Image size 1440x1080; Natus RetCam Envision, 130° FOV; pediatric wide-field fundus photograph: 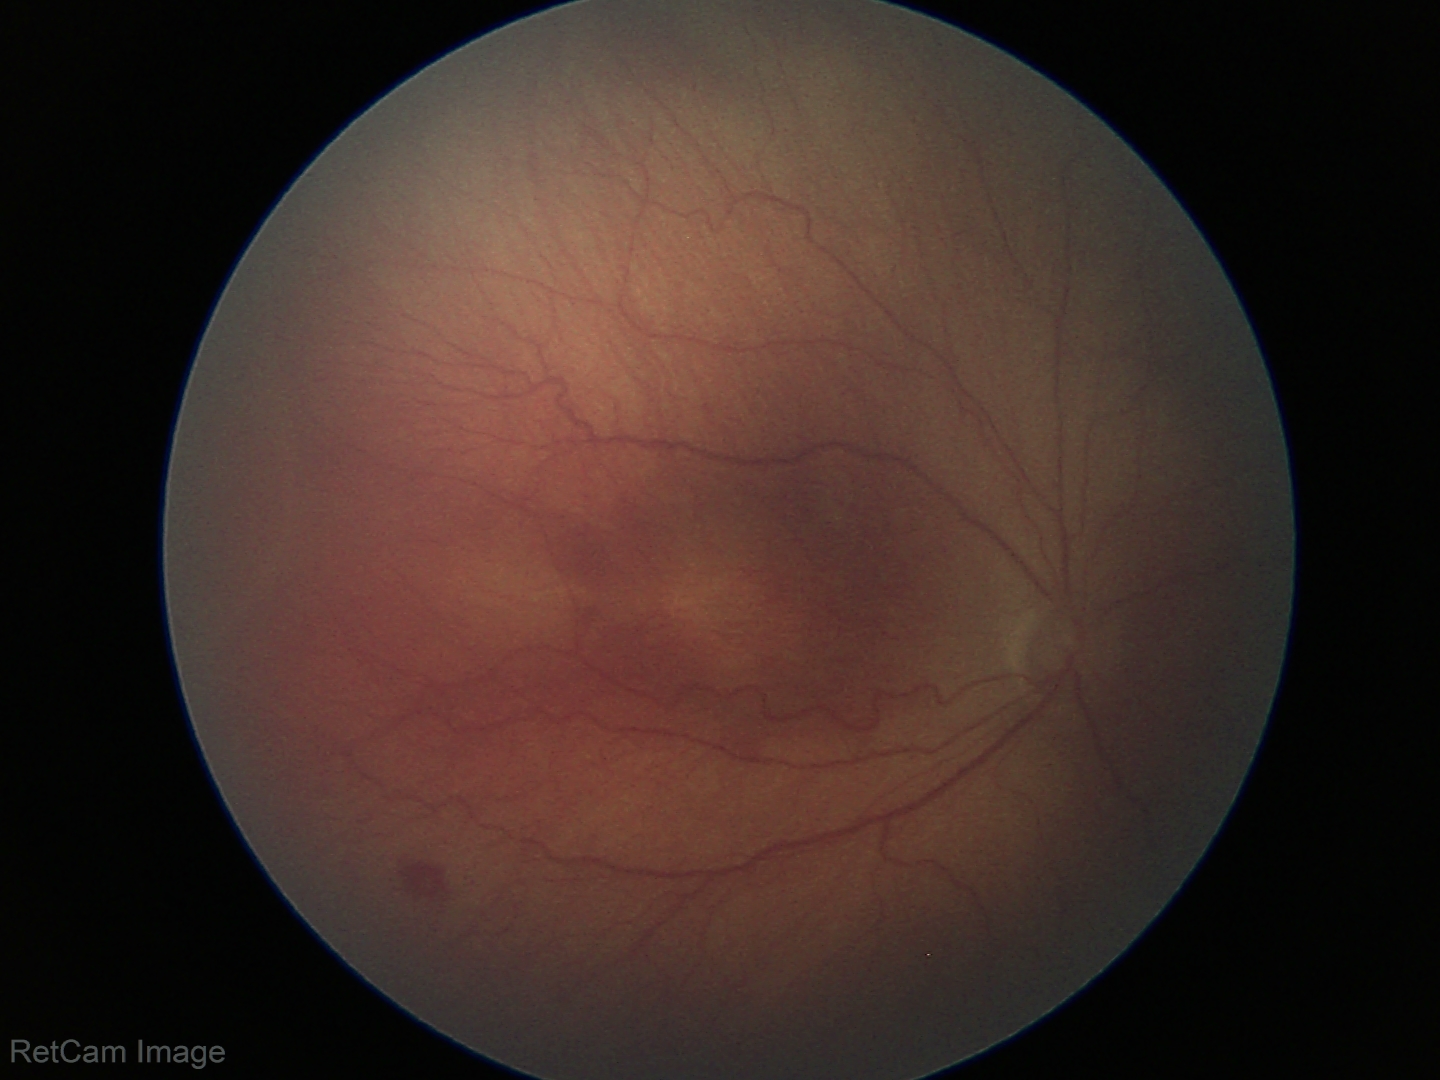

Q: What is the diagnosis from this examination?
A: ROP stage 3 — ridge with extraretinal fibrovascular proliferation